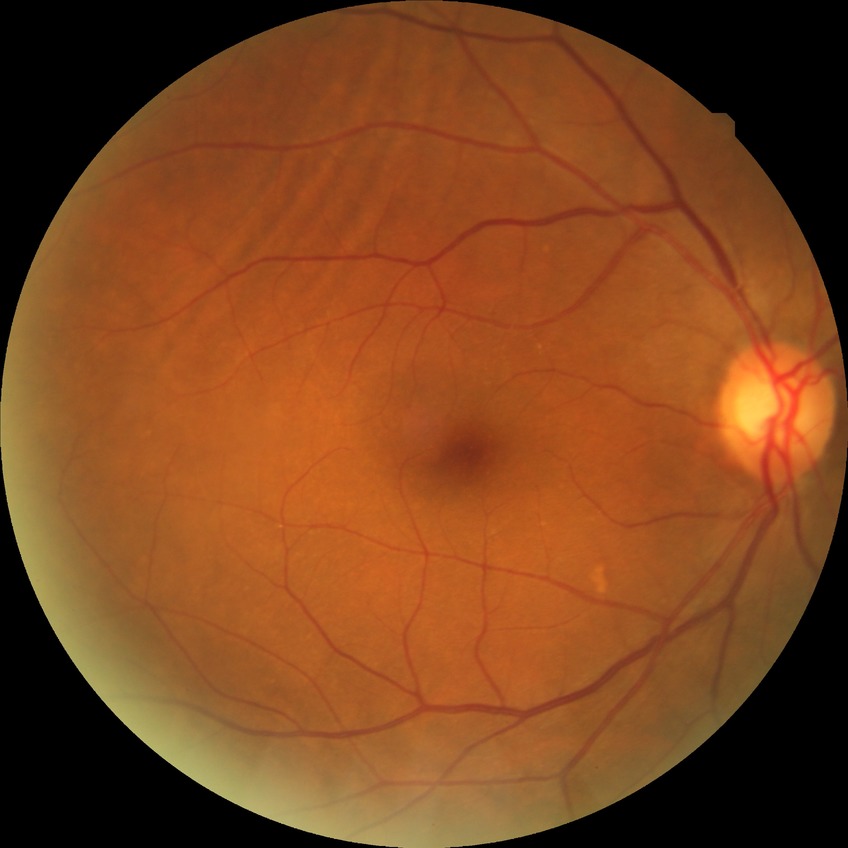 Diabetic retinopathy grade is no diabetic retinopathy.